Centered on the optic disc
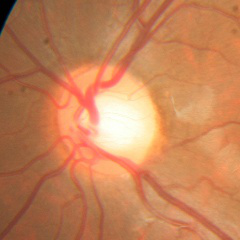 No signs of glaucoma.